Camera: Topcon TRC-NW8 · 50-degree field of view.
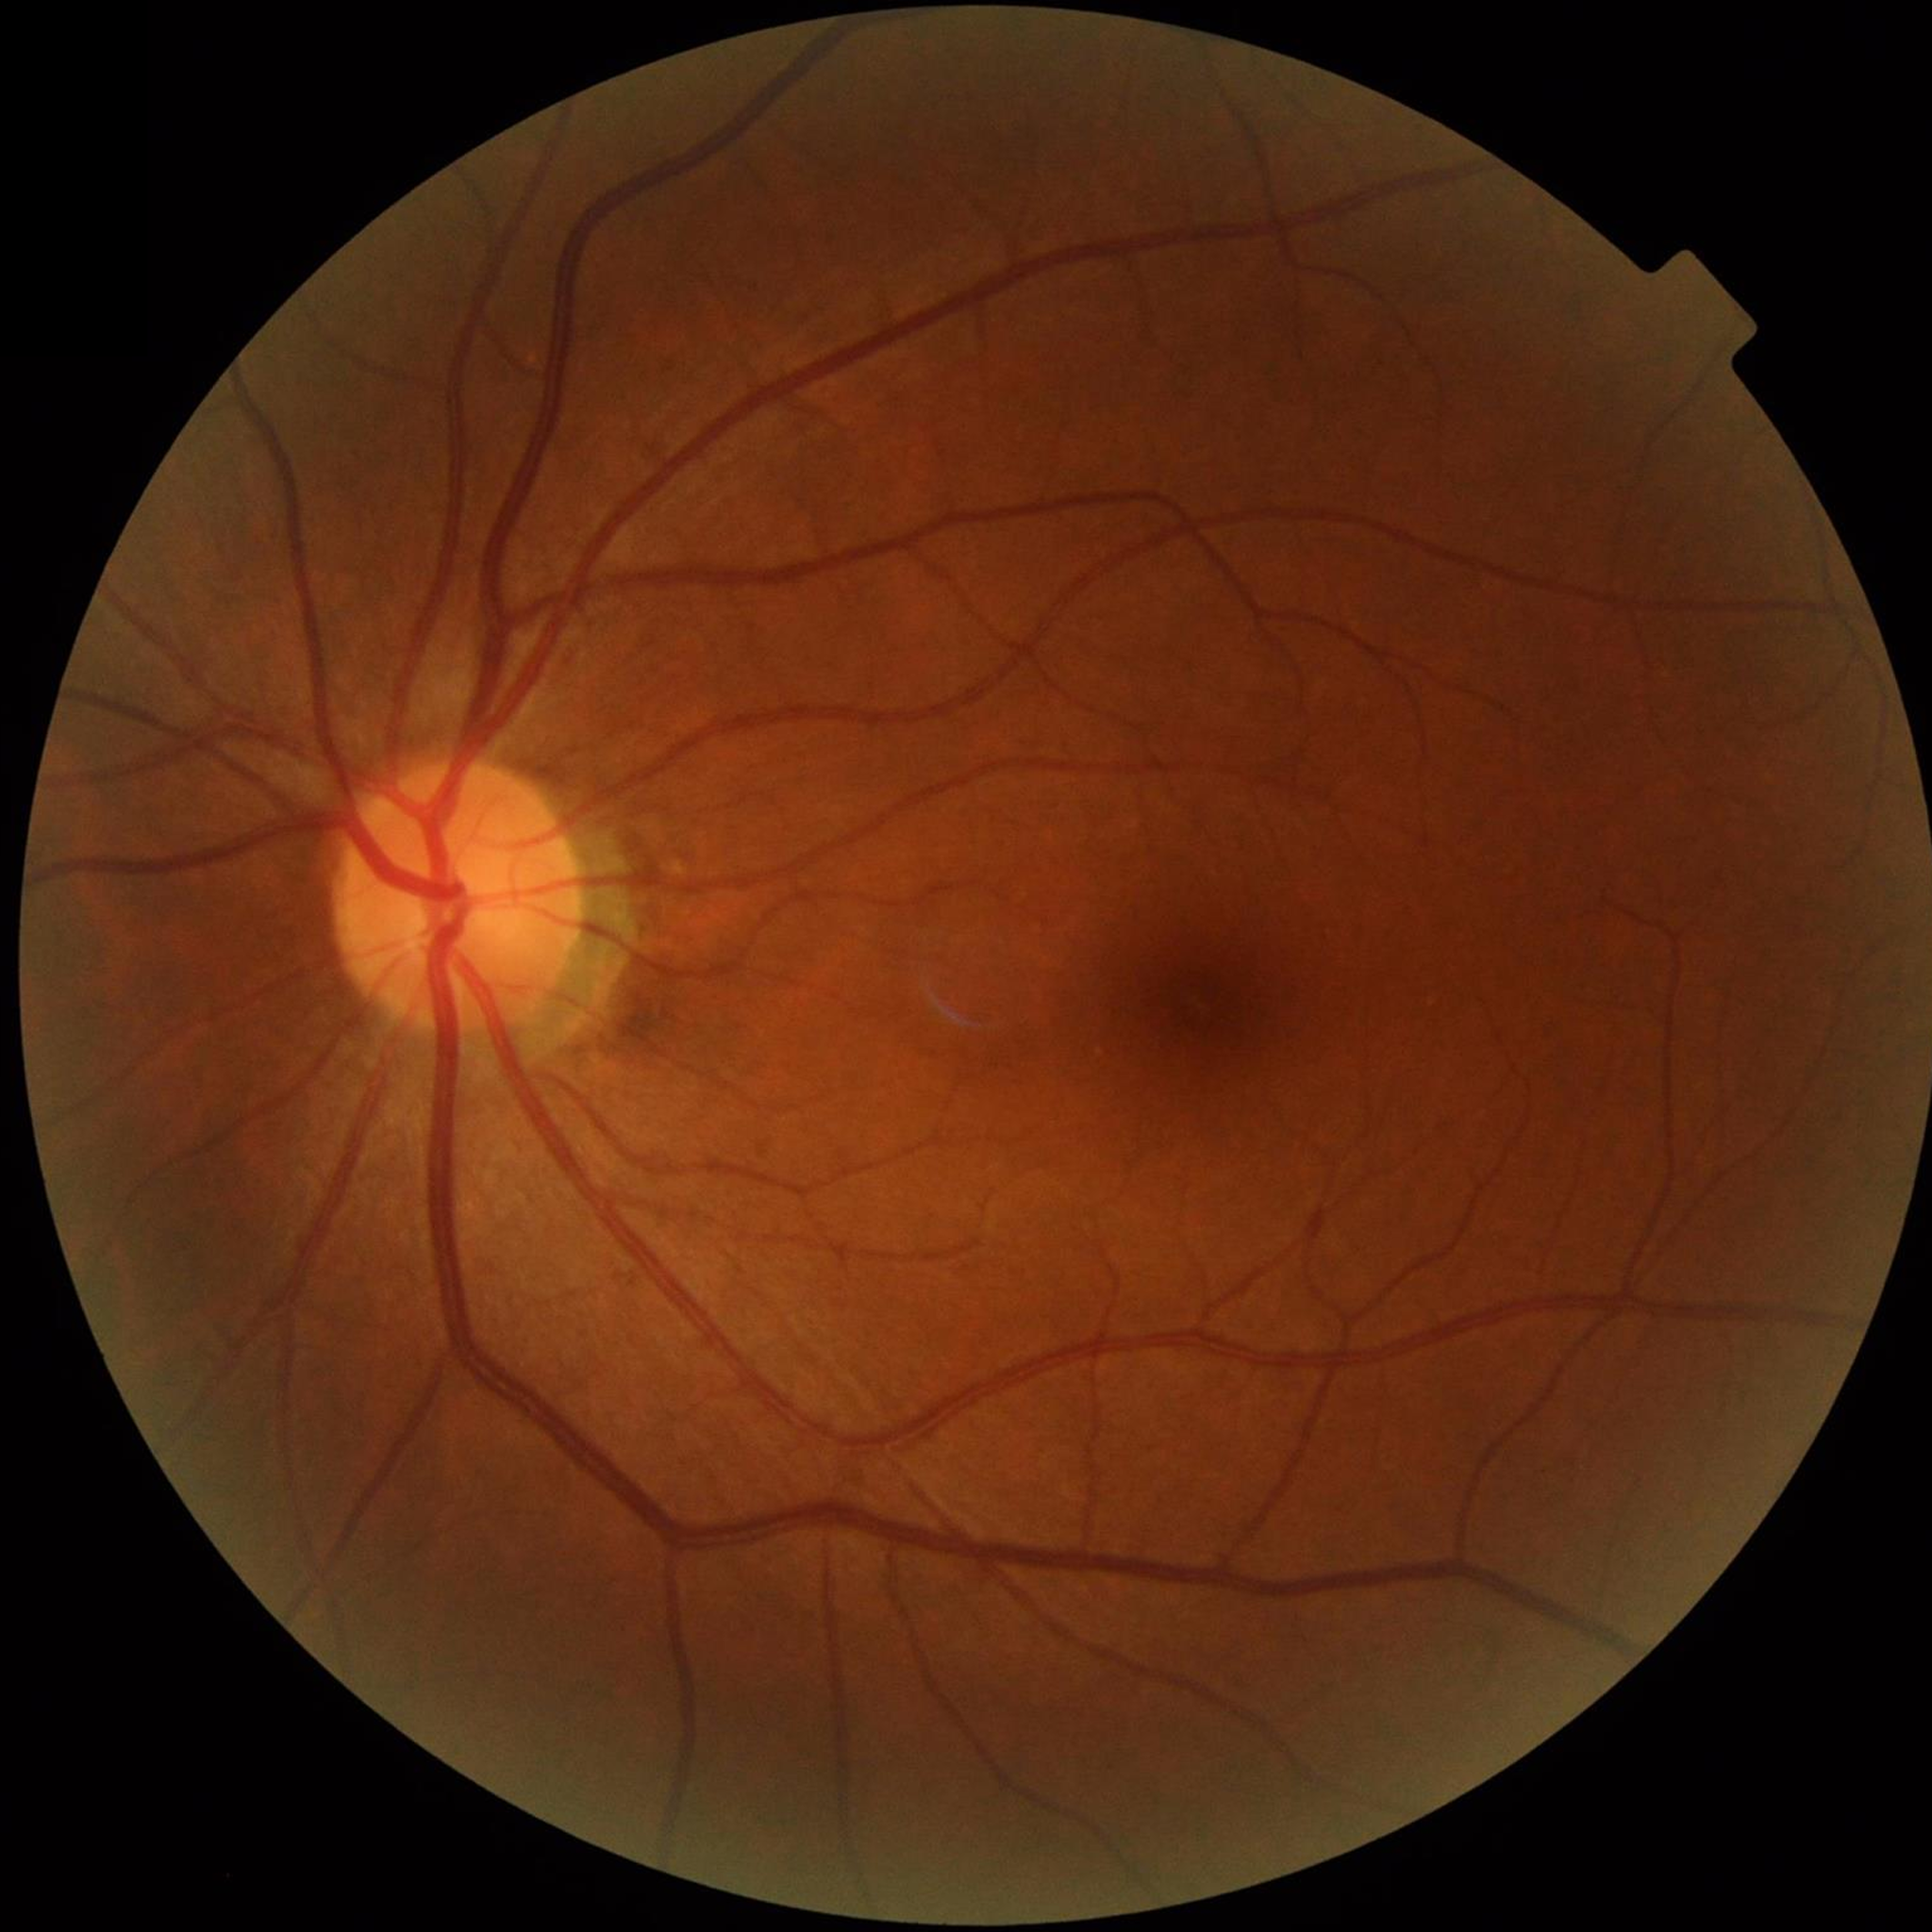
  diagnosis: control (no AMD/DR/glaucoma)